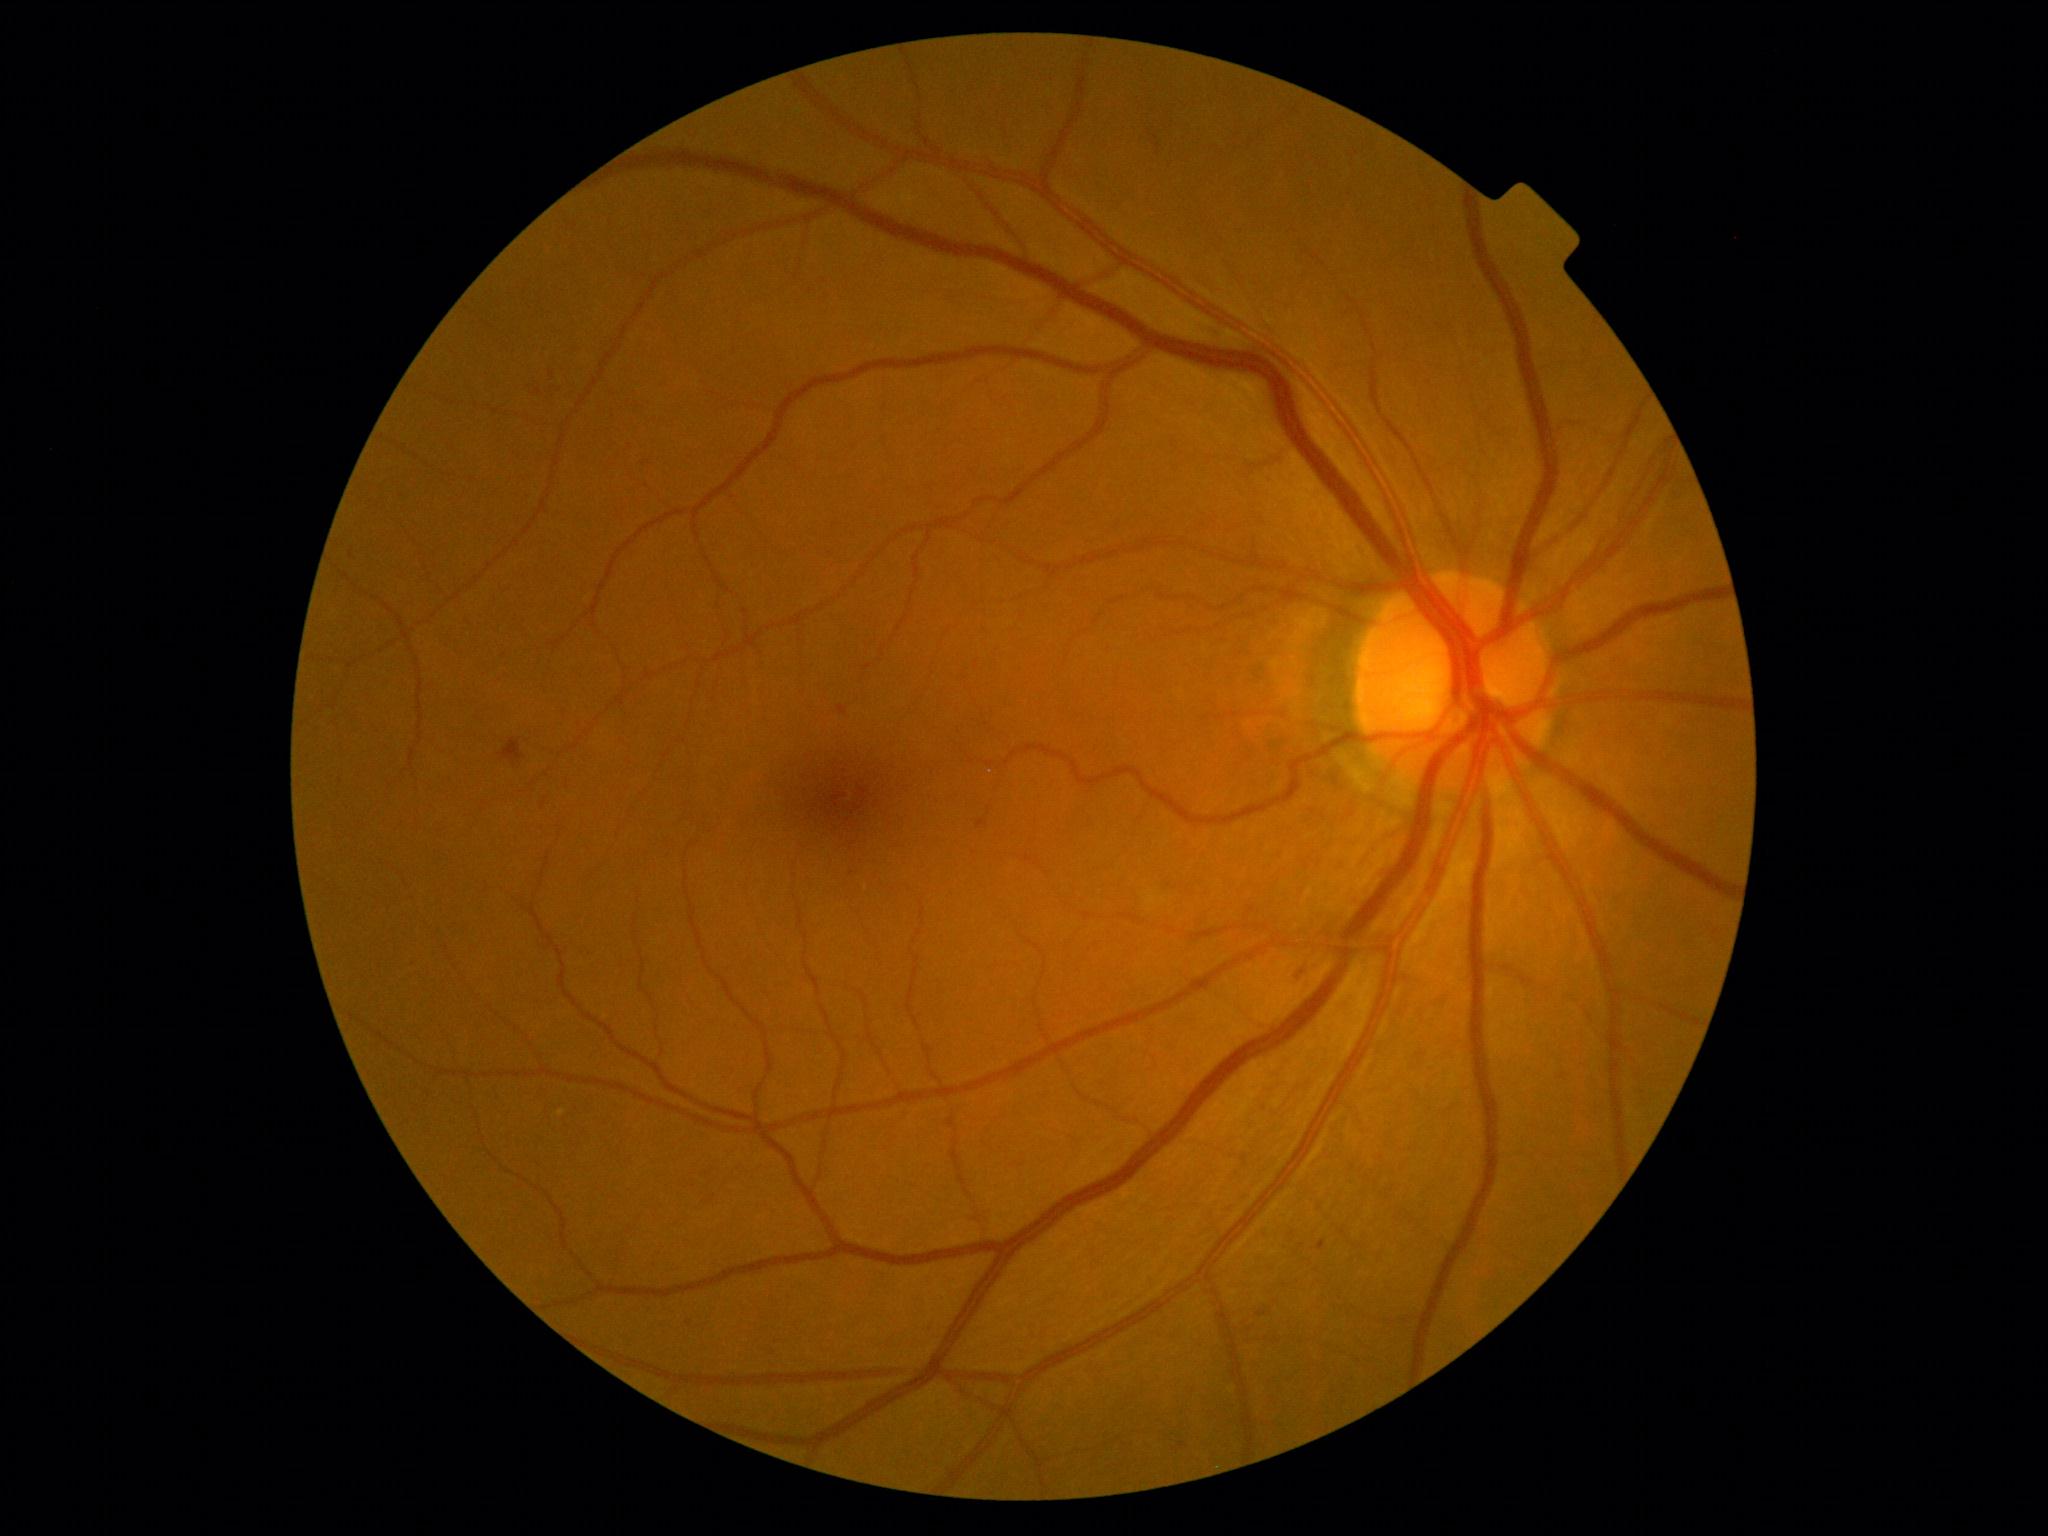
Diabetic retinopathy (DR): 2/4.